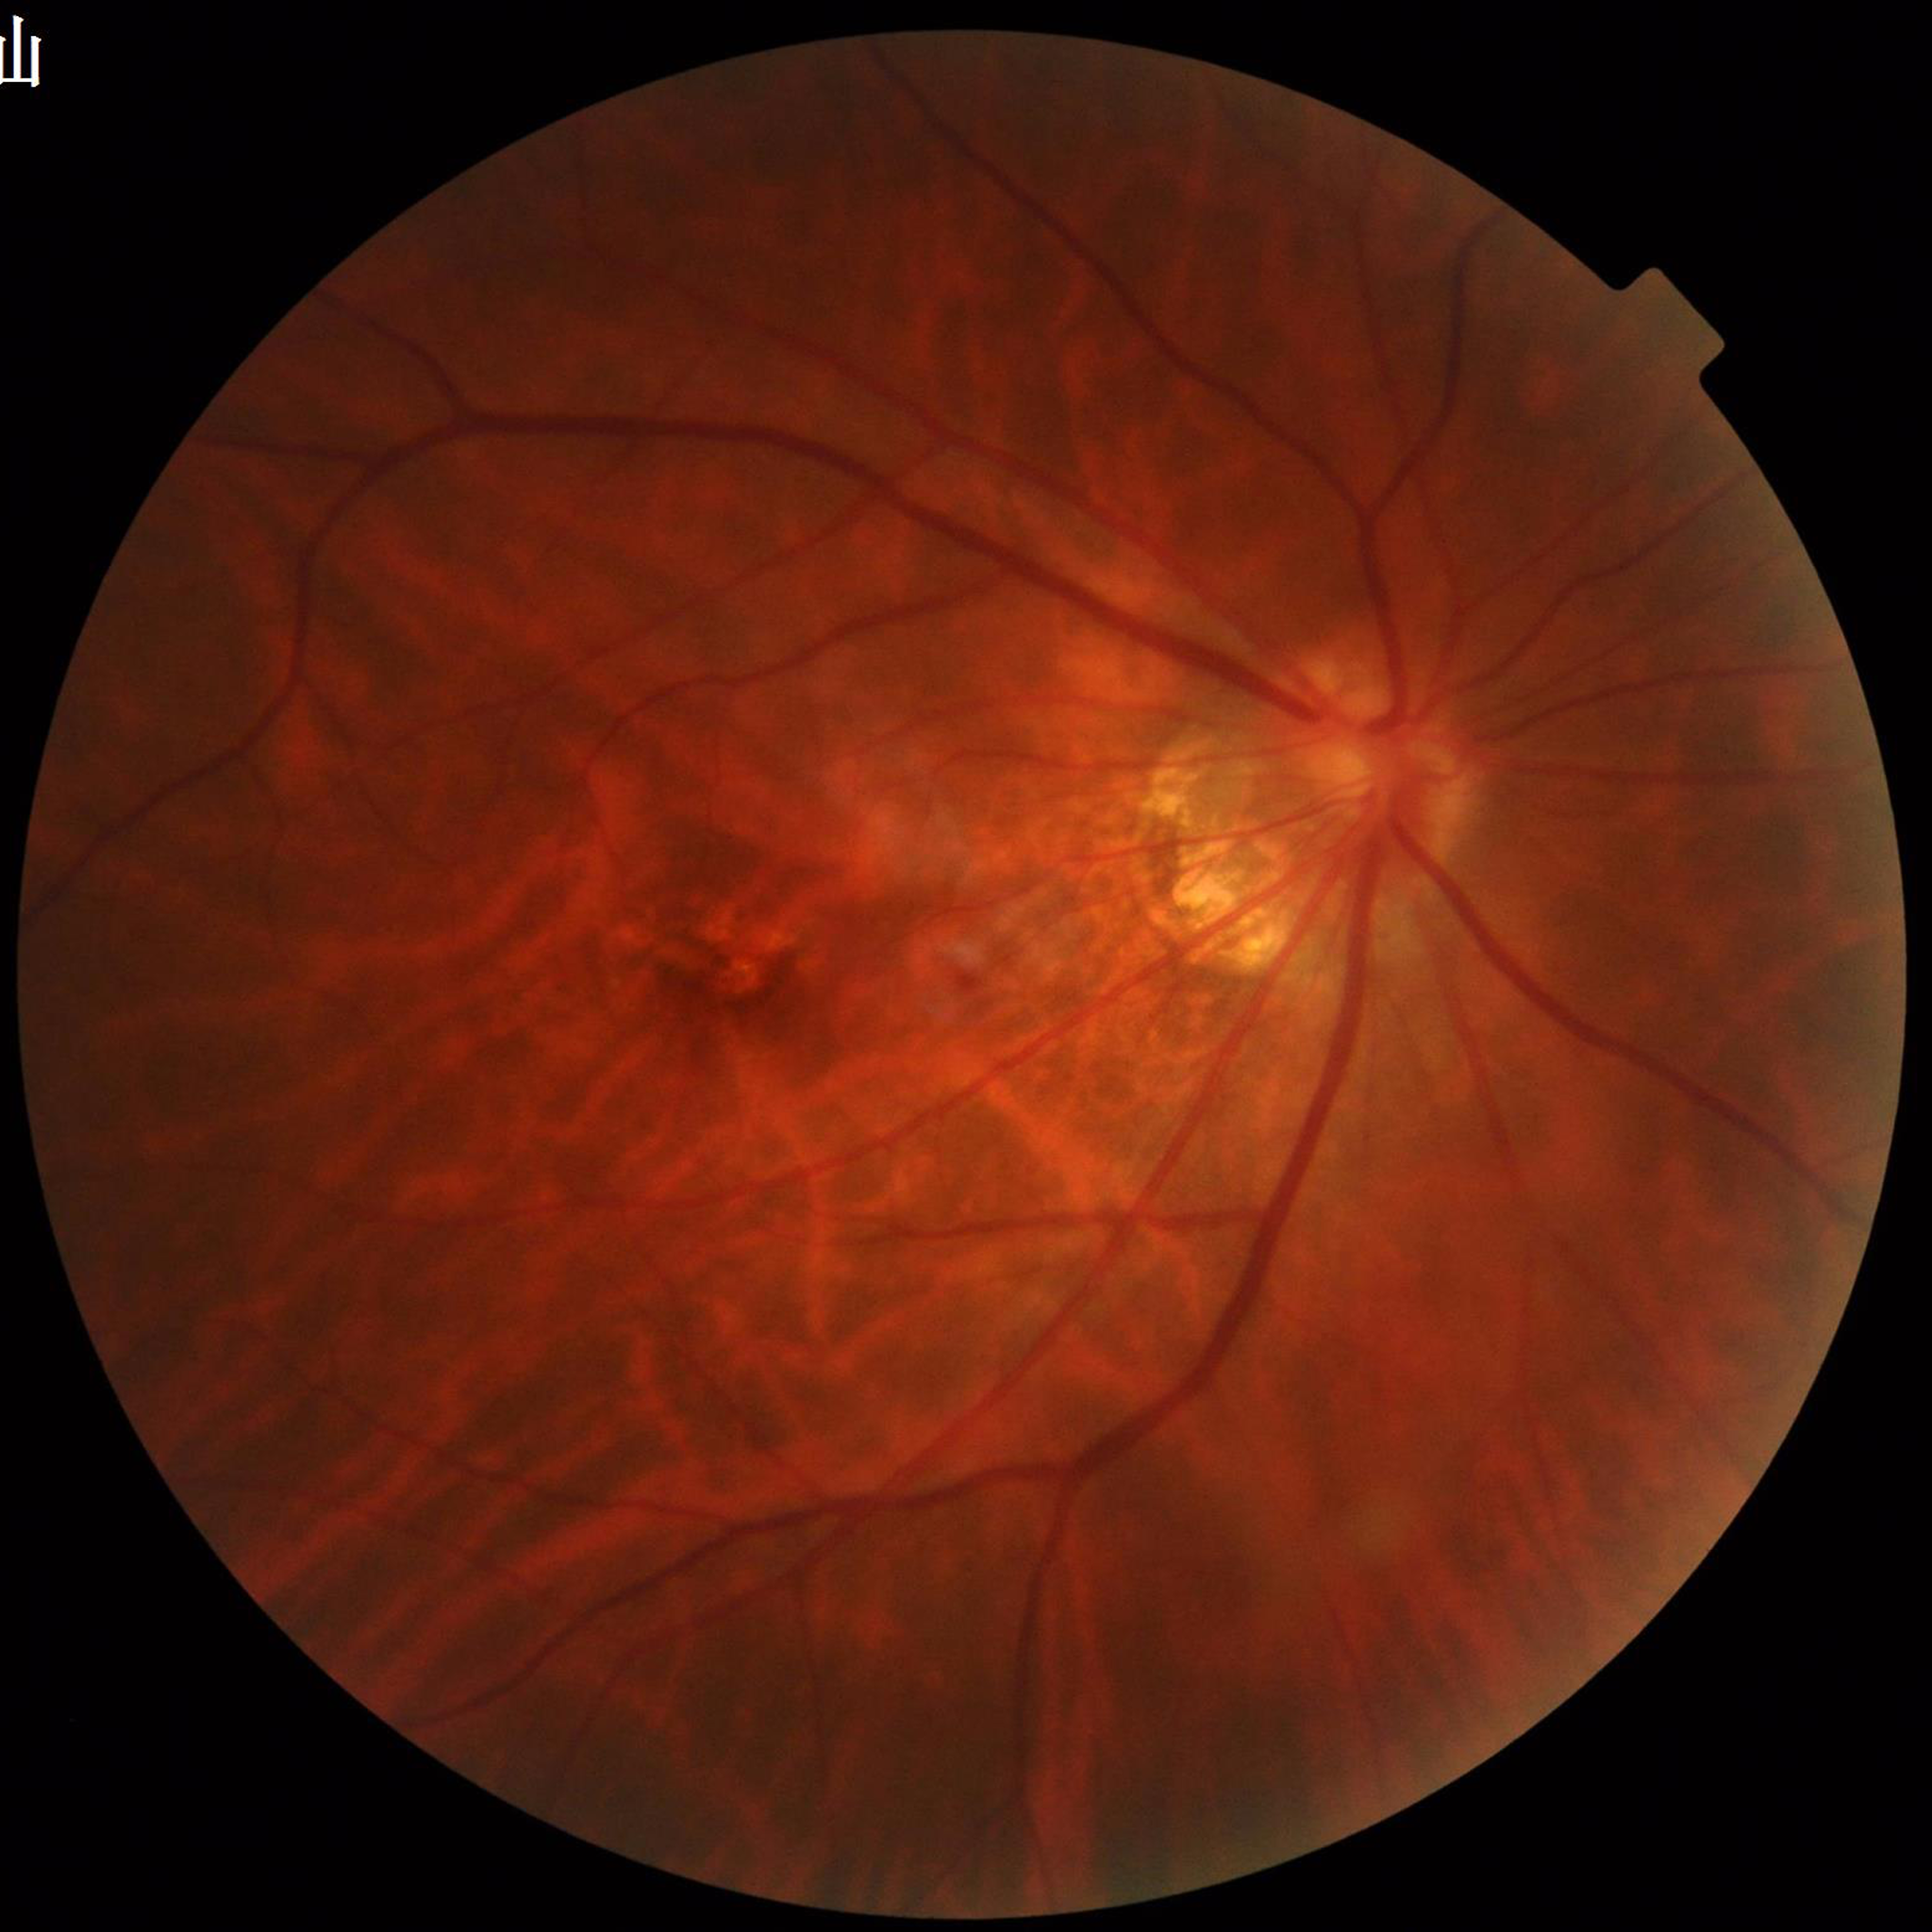
Color fundus photograph from a patient diagnosed with AMD. Photo quality: no concerns identified.